CFP — 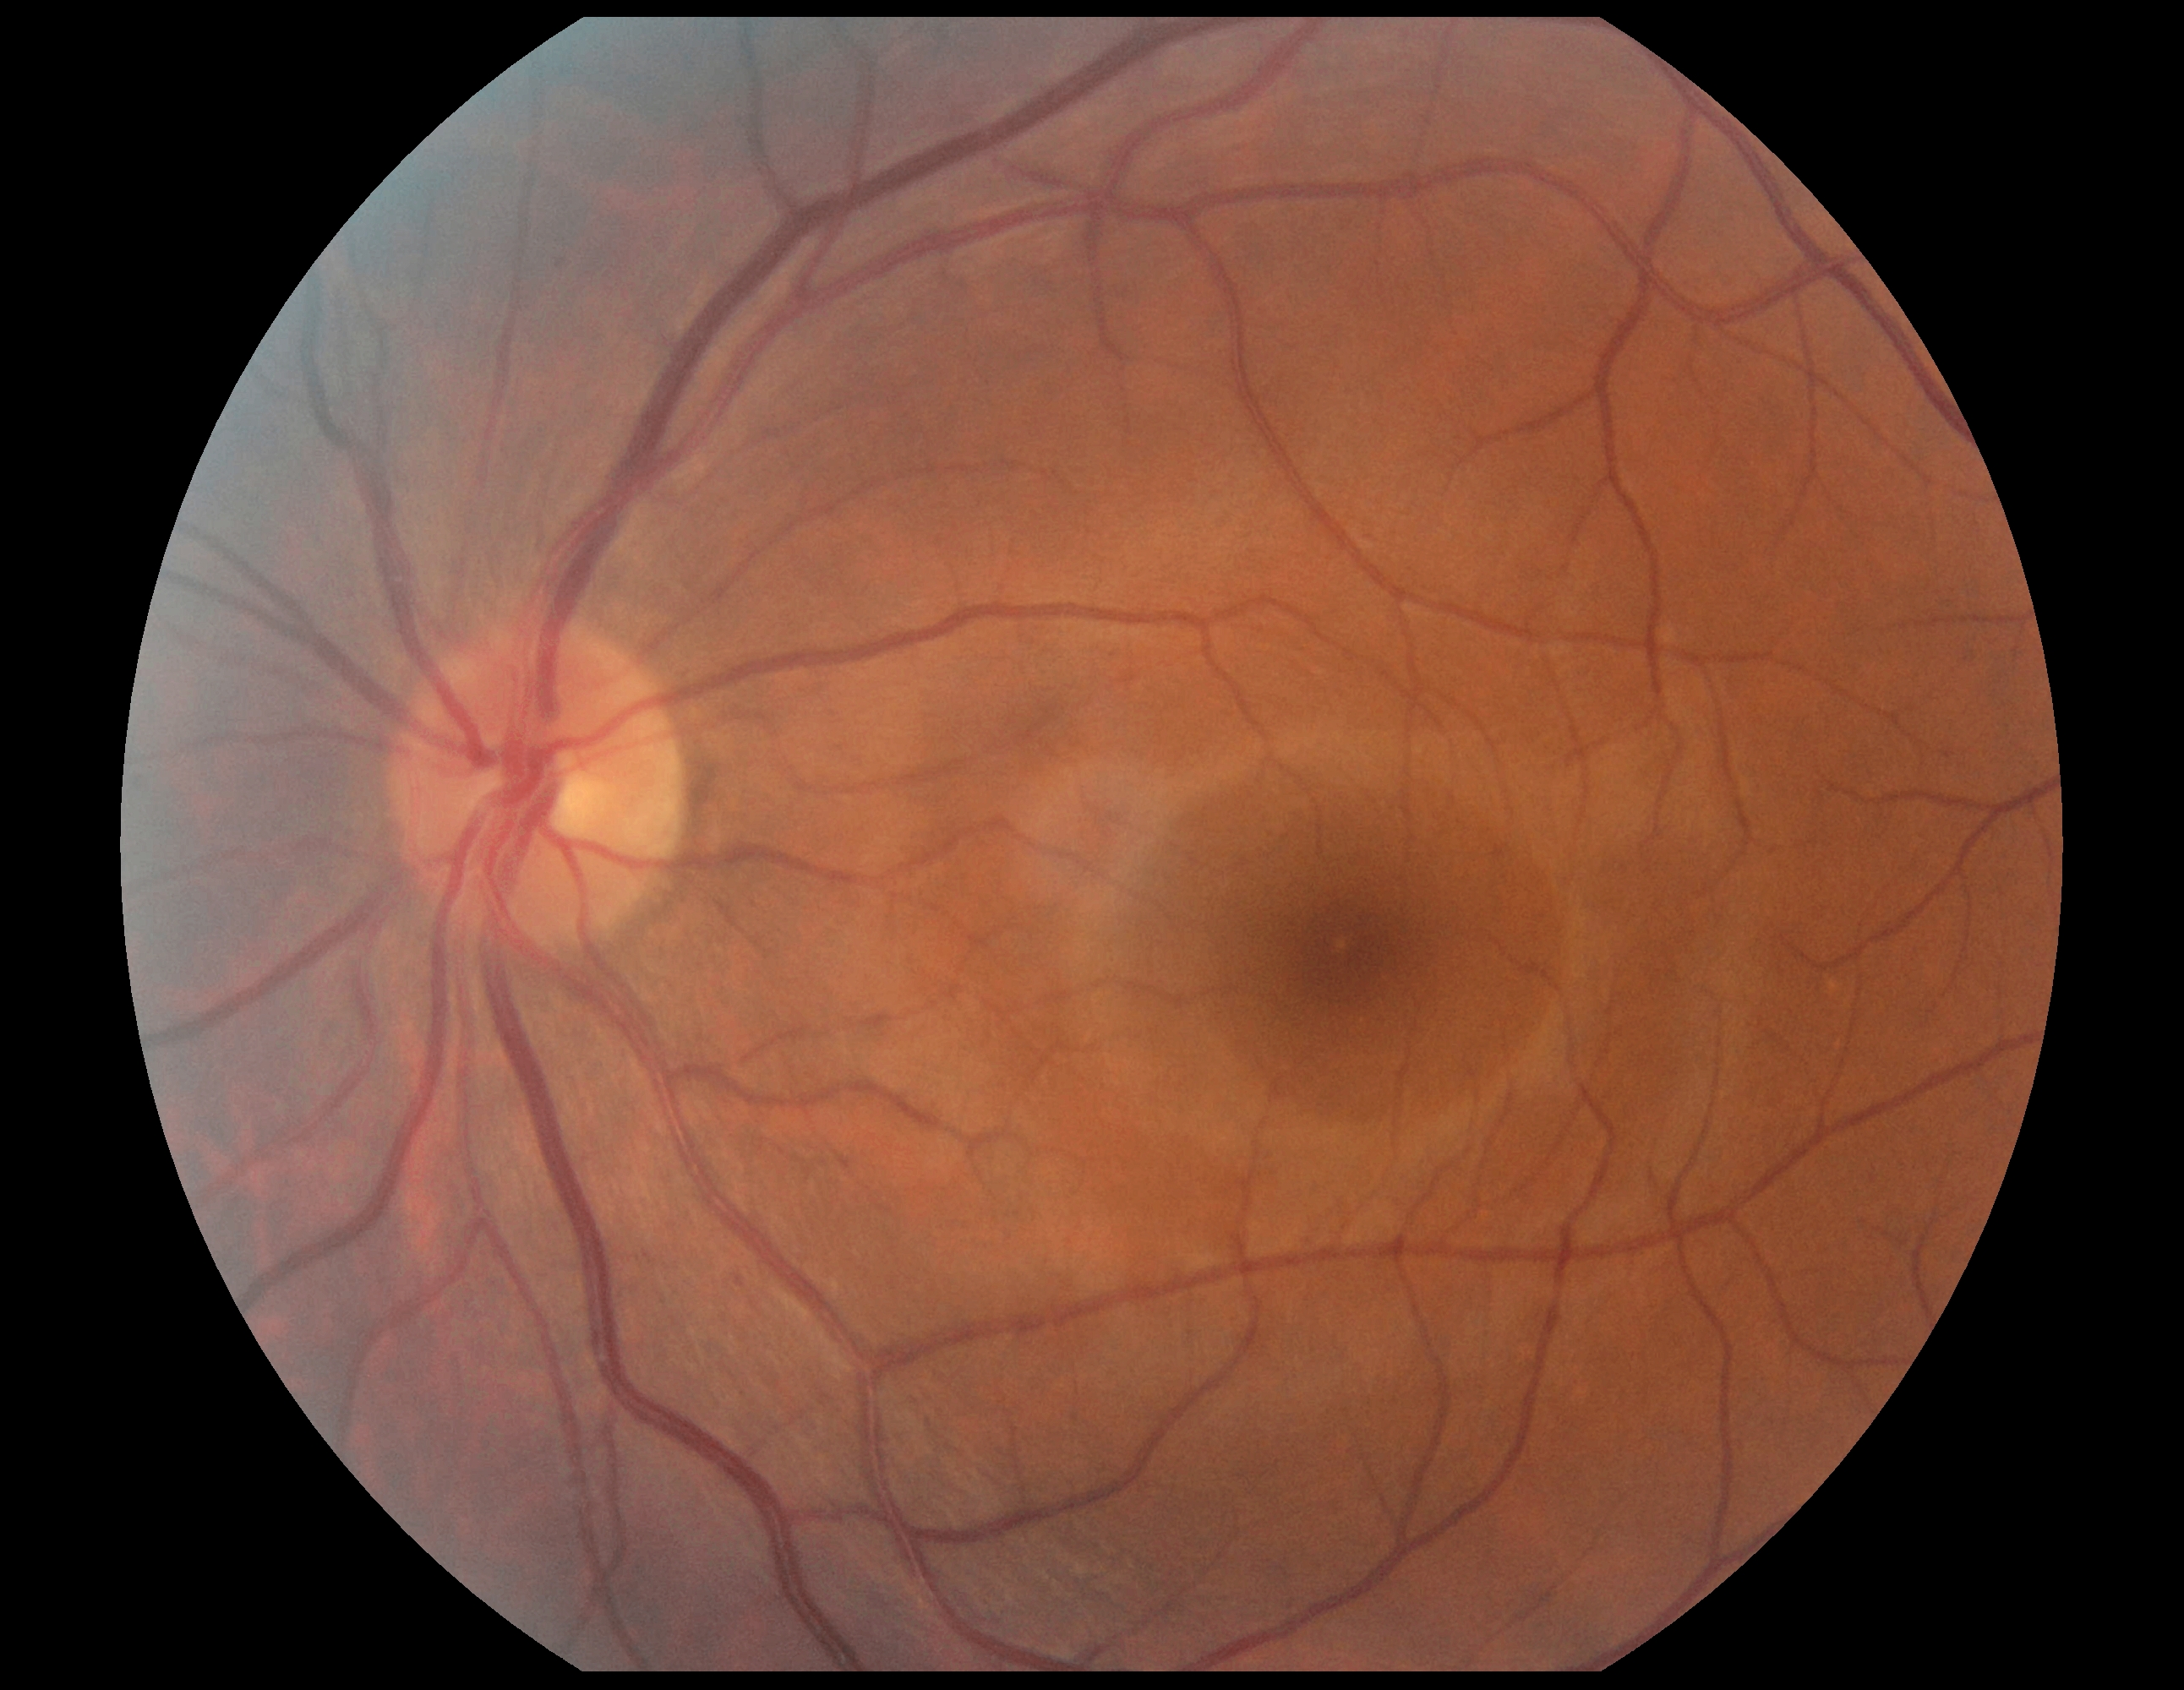
No DR findings.
Diabetic retinopathy is grade 0.